FOV: 45 degrees: 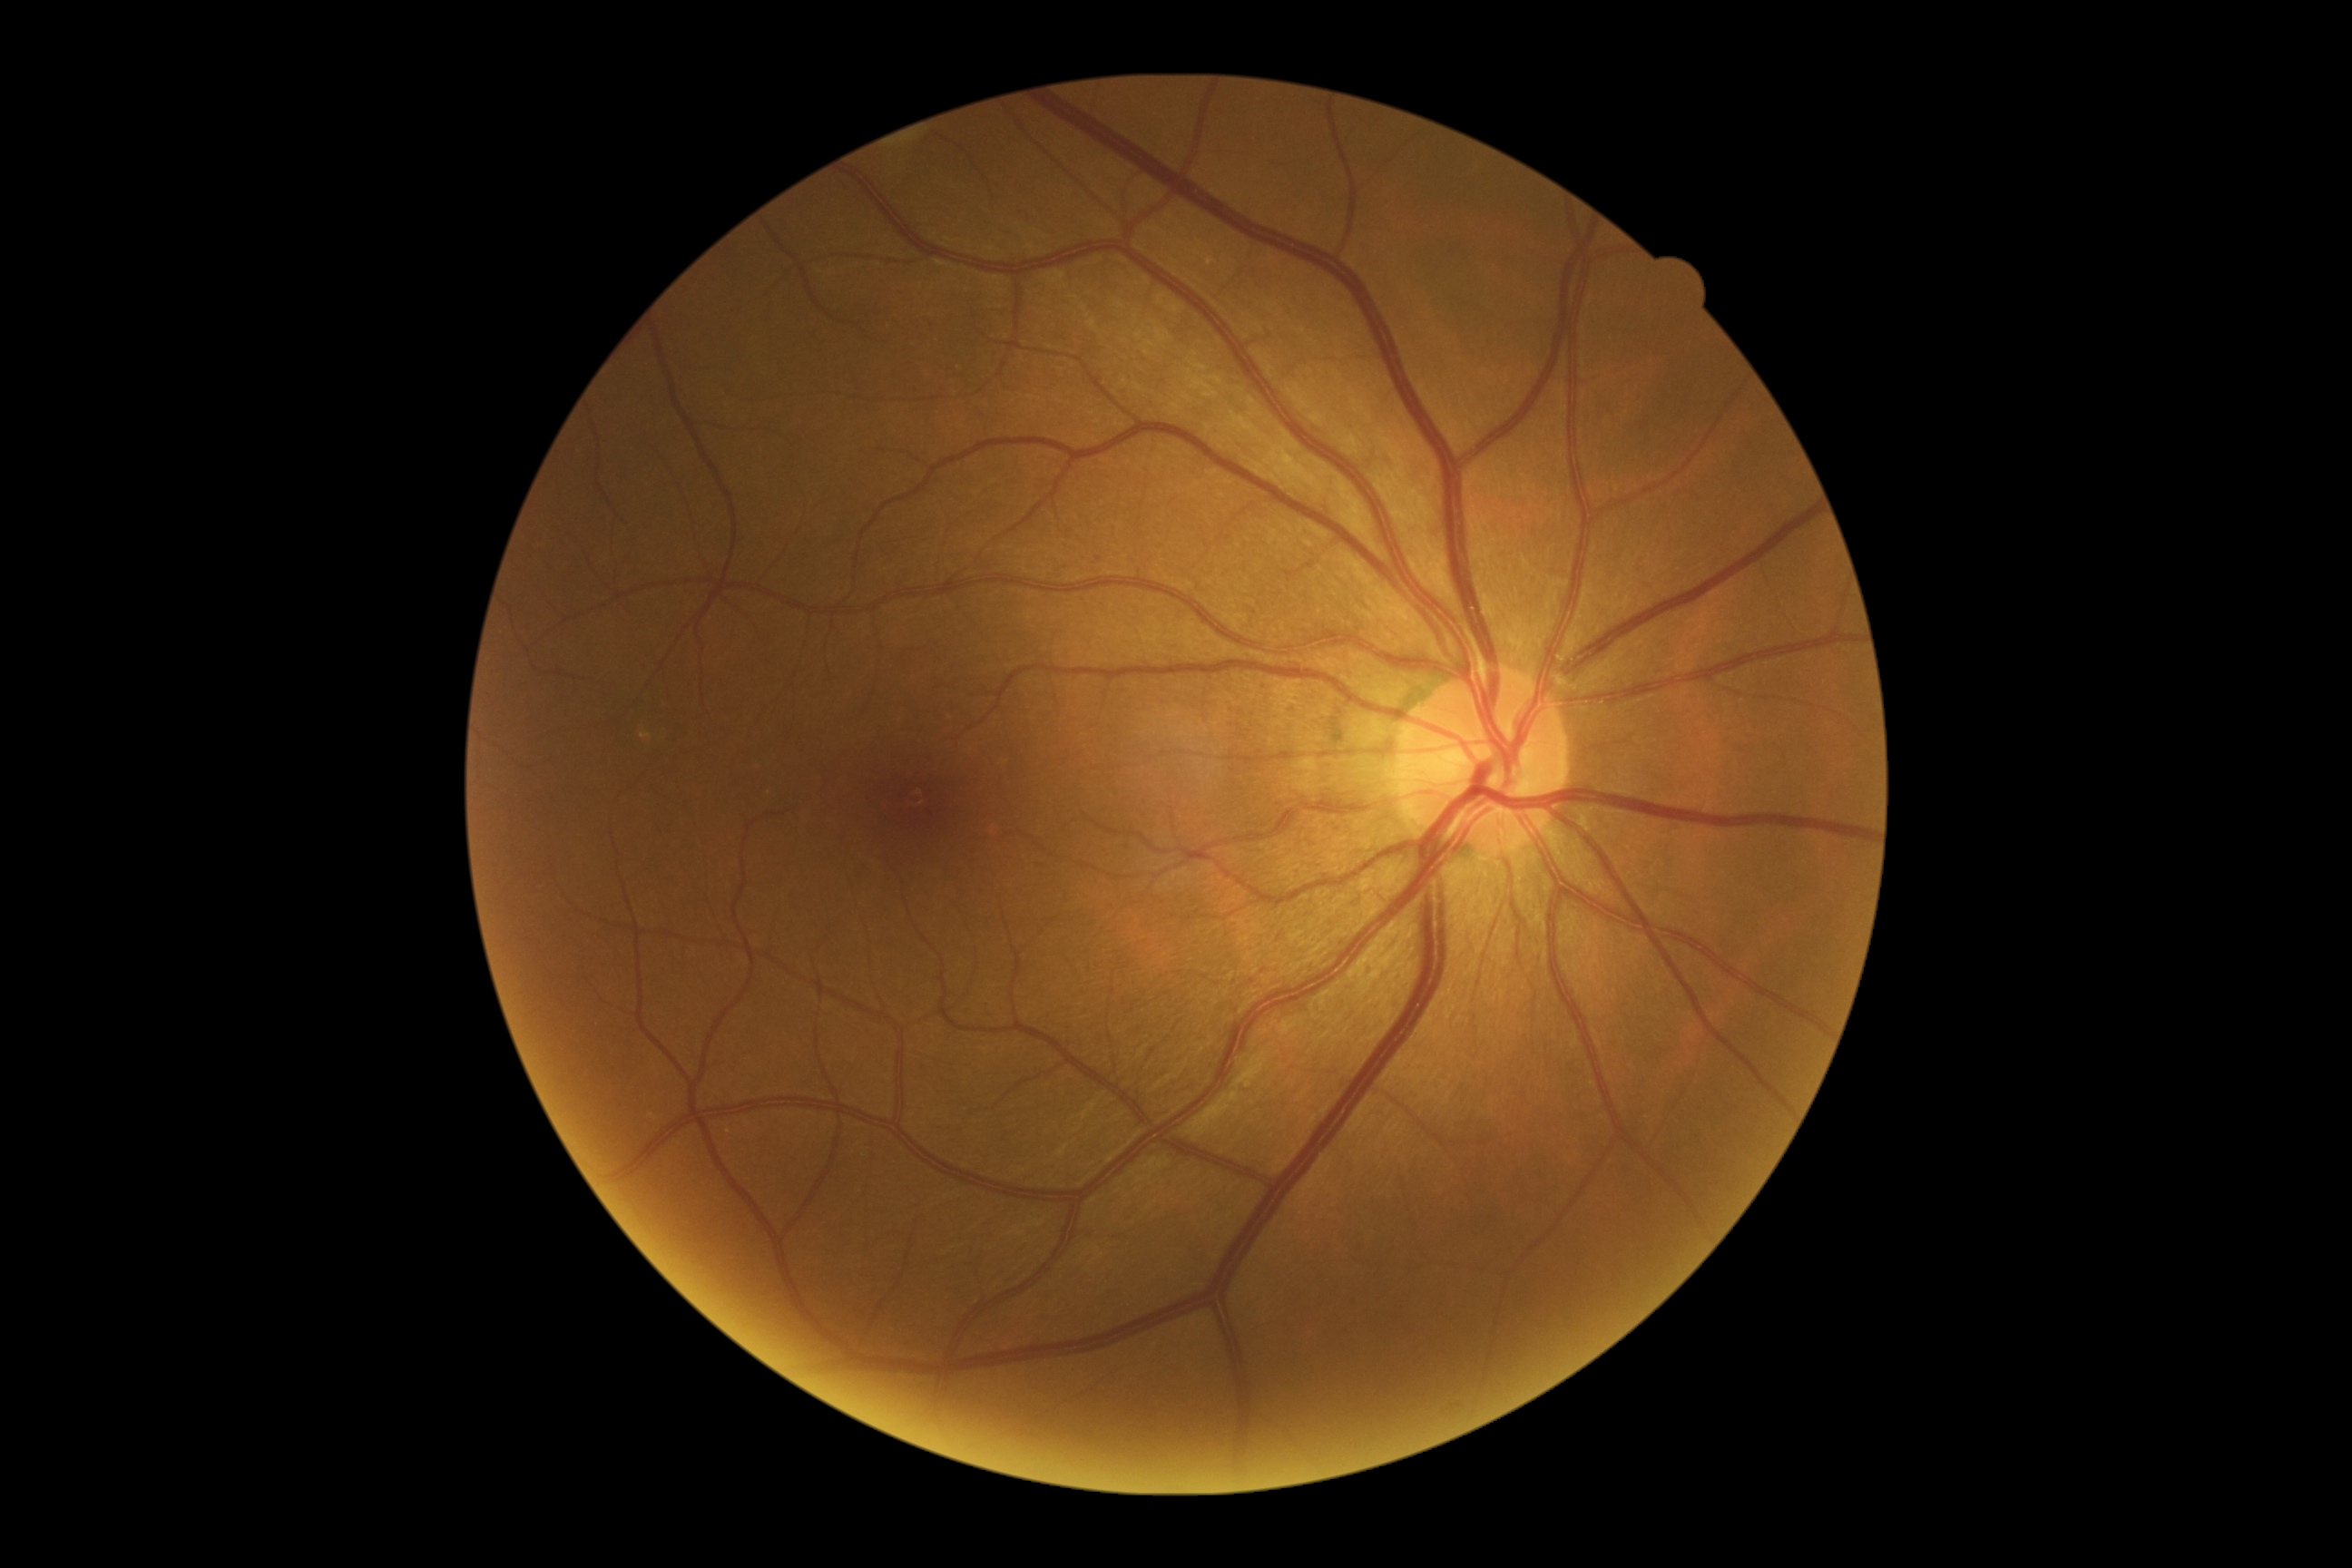
retinopathy grade: 0 (no apparent retinopathy)